1659x2212px — 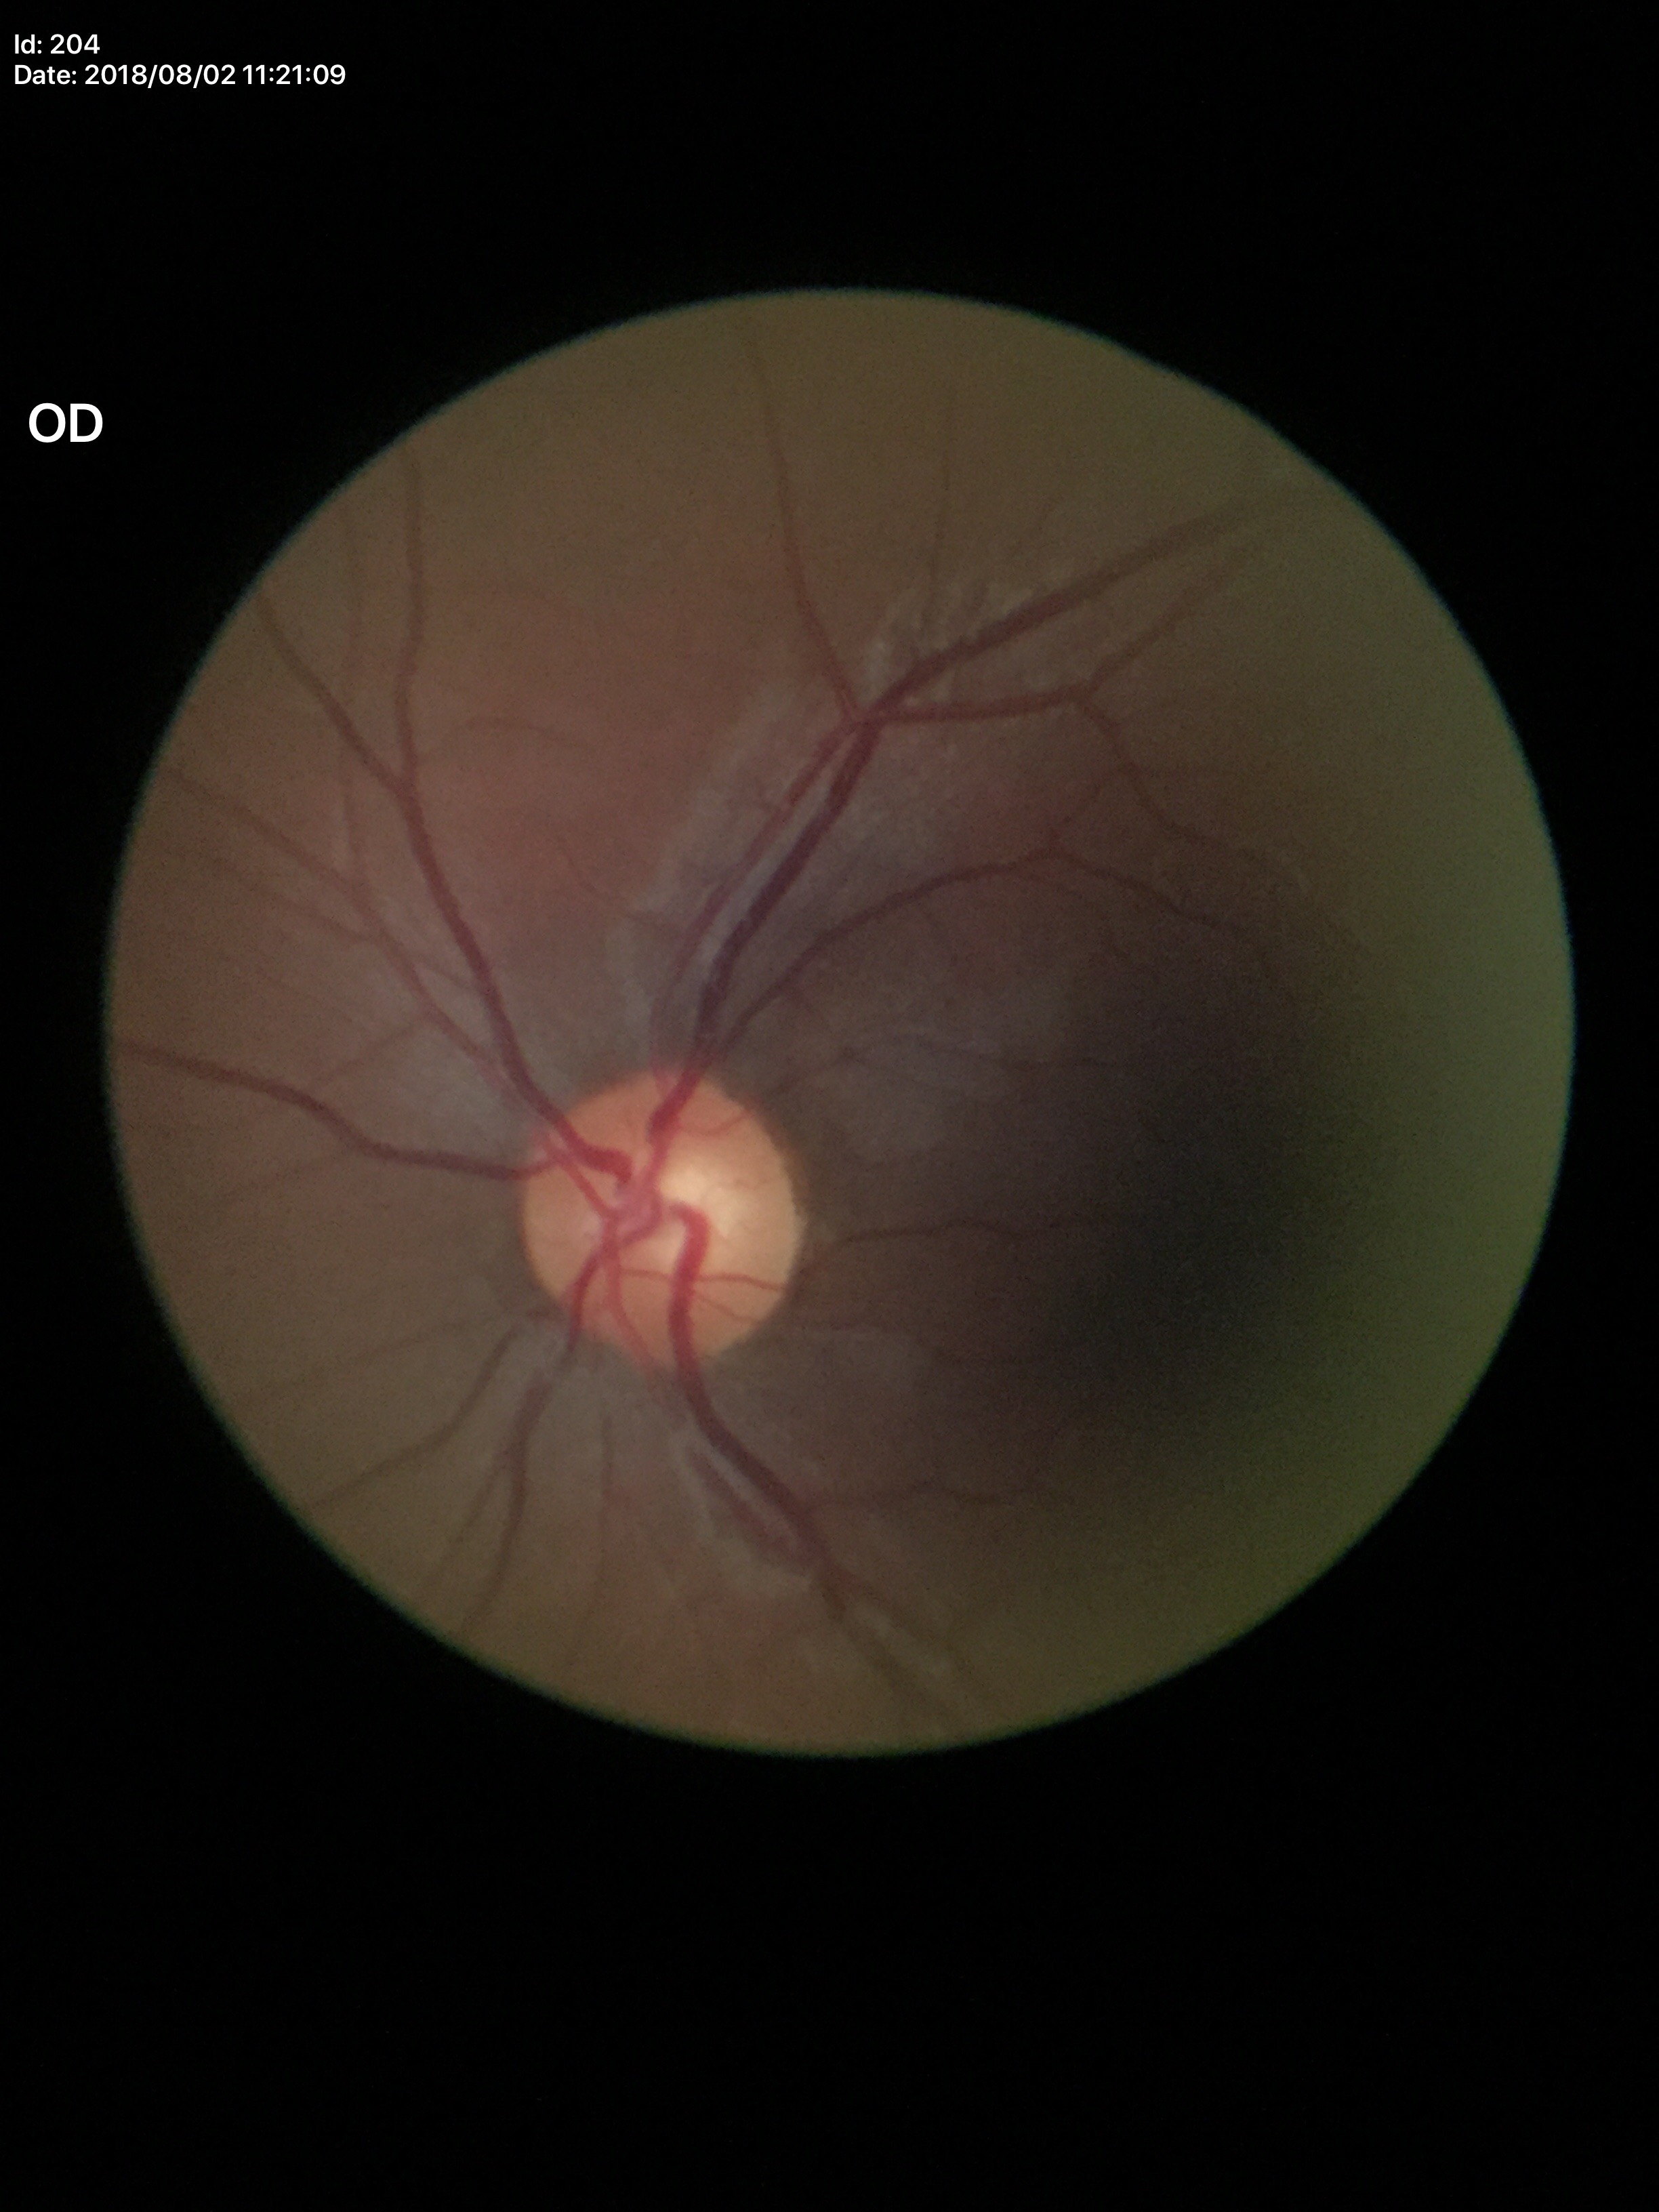

glaucoma_decision: no suspicious findings
vcdr: 0.53